Image size 848x848; acquired with a NIDEK AFC-230; diabetic retinopathy graded by the modified Davis classification:
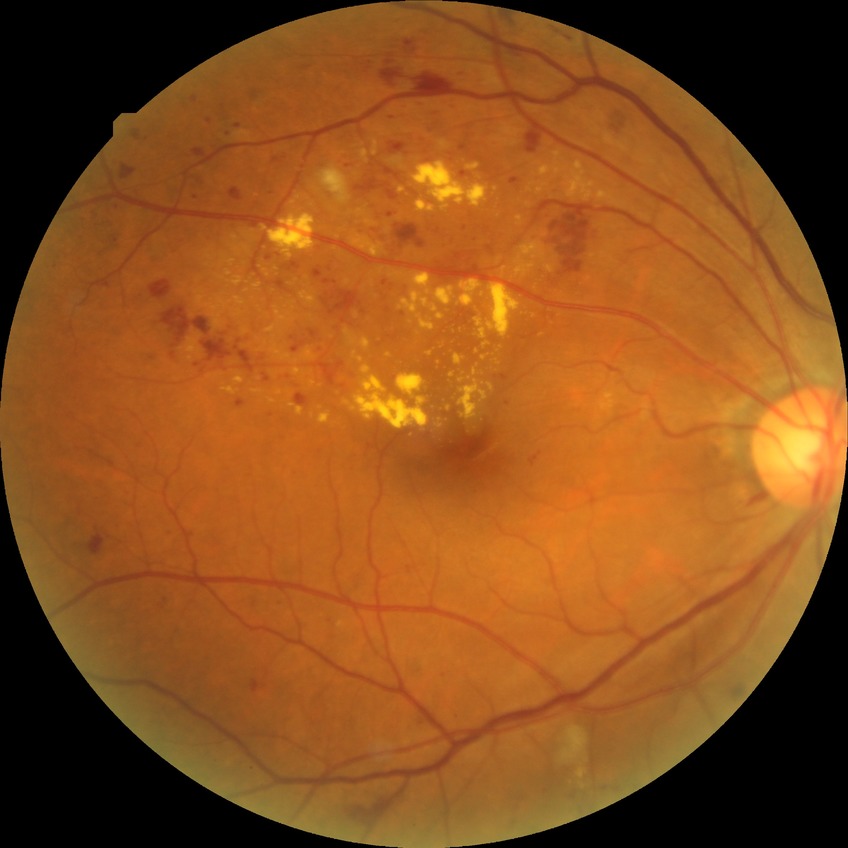

Diabetic retinopathy (DR) is PPDR (pre-proliferative diabetic retinopathy).